Nonmydriatic fundus photograph; NIDEK AFC-230:
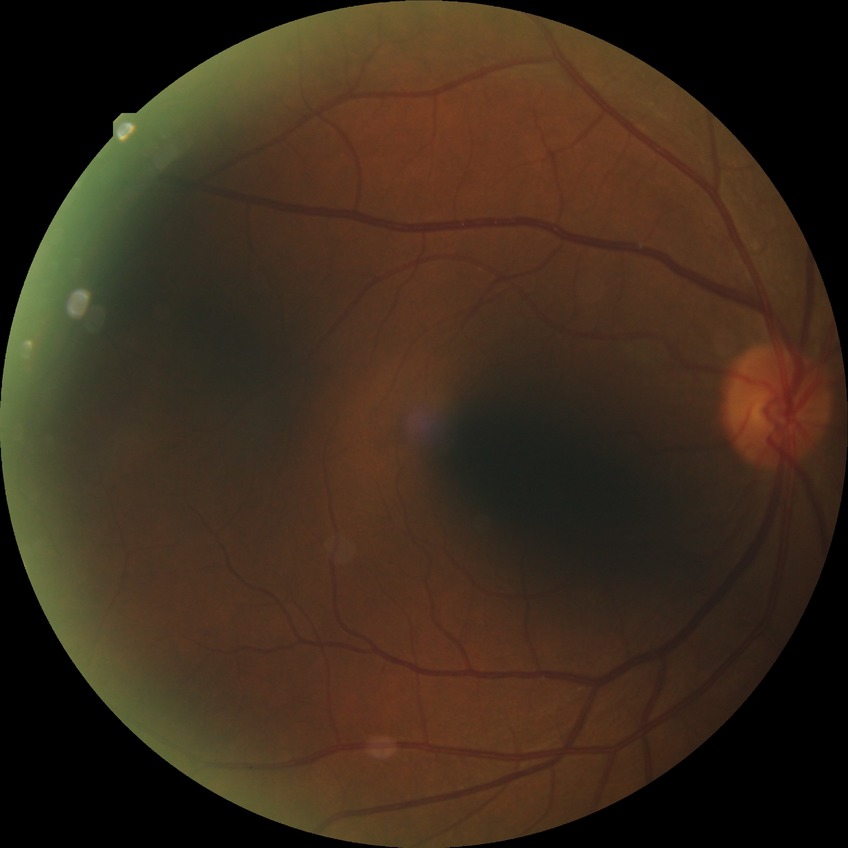 Diabetic retinopathy (DR) is simple diabetic retinopathy (SDR).